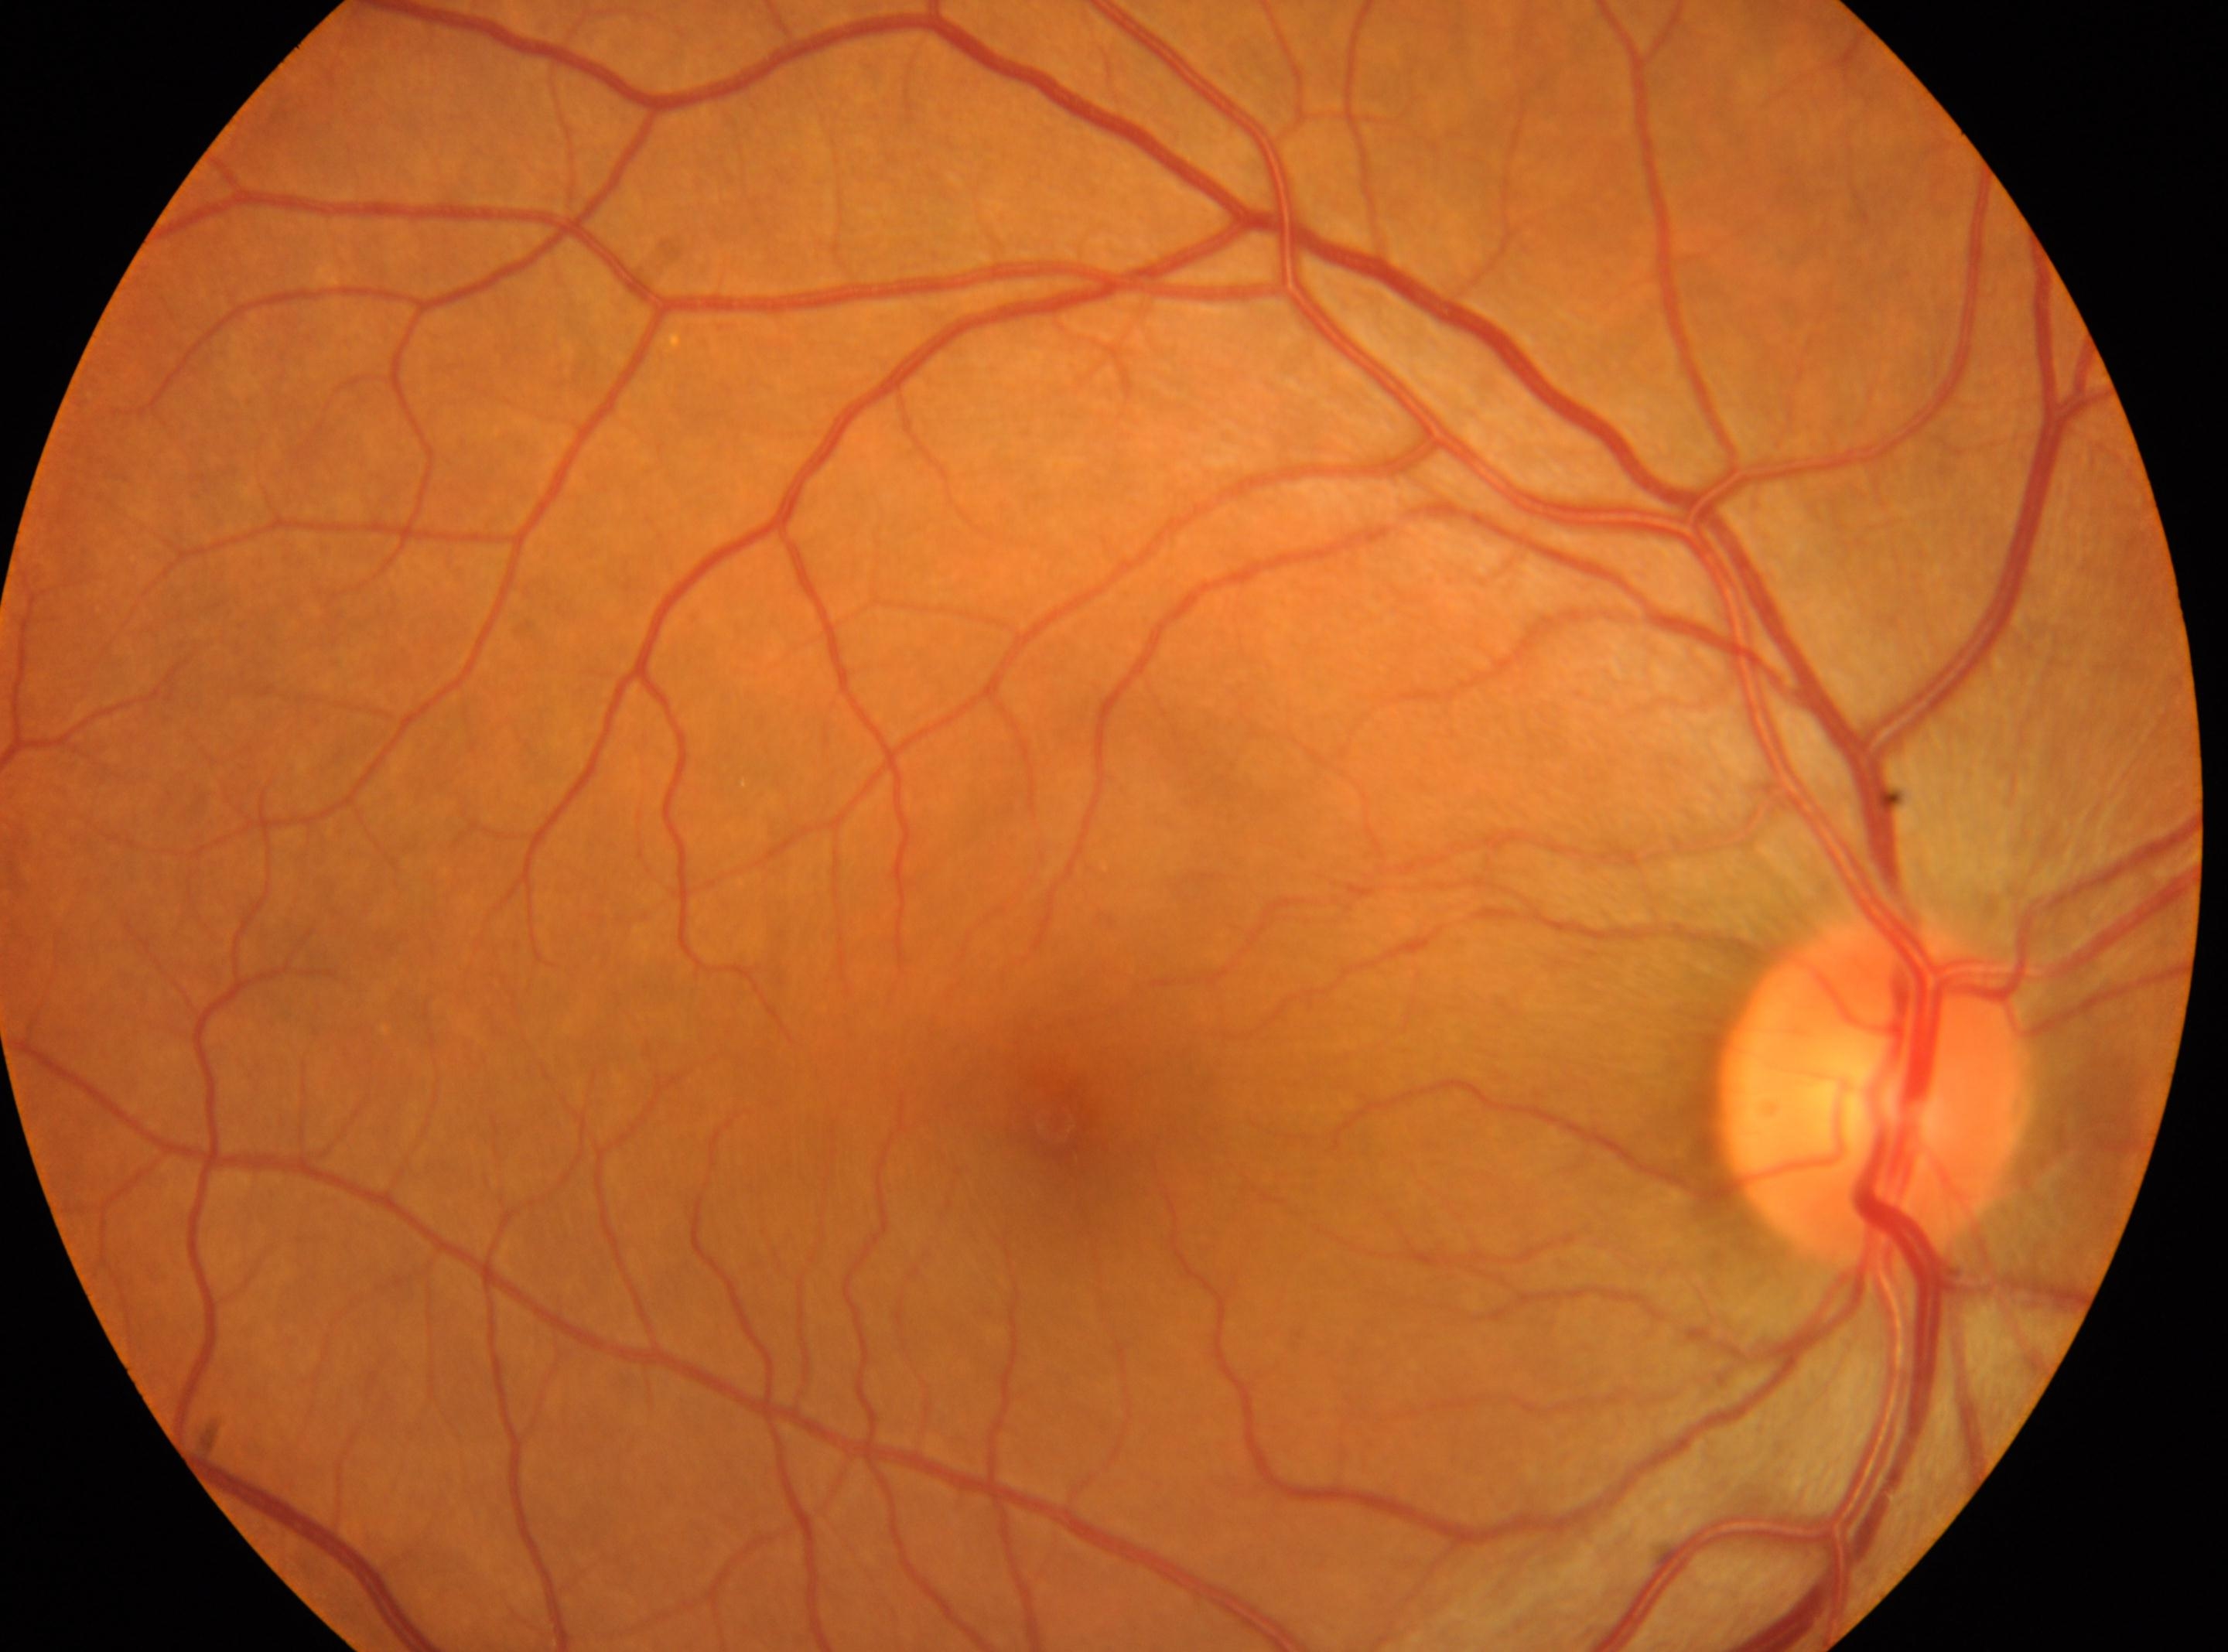
DR severity is grade 0 (no apparent retinopathy). Macular center: (x: 1055, y: 1123). Optic nerve head located at (x: 1869, y: 1091). The image shows the right eye.